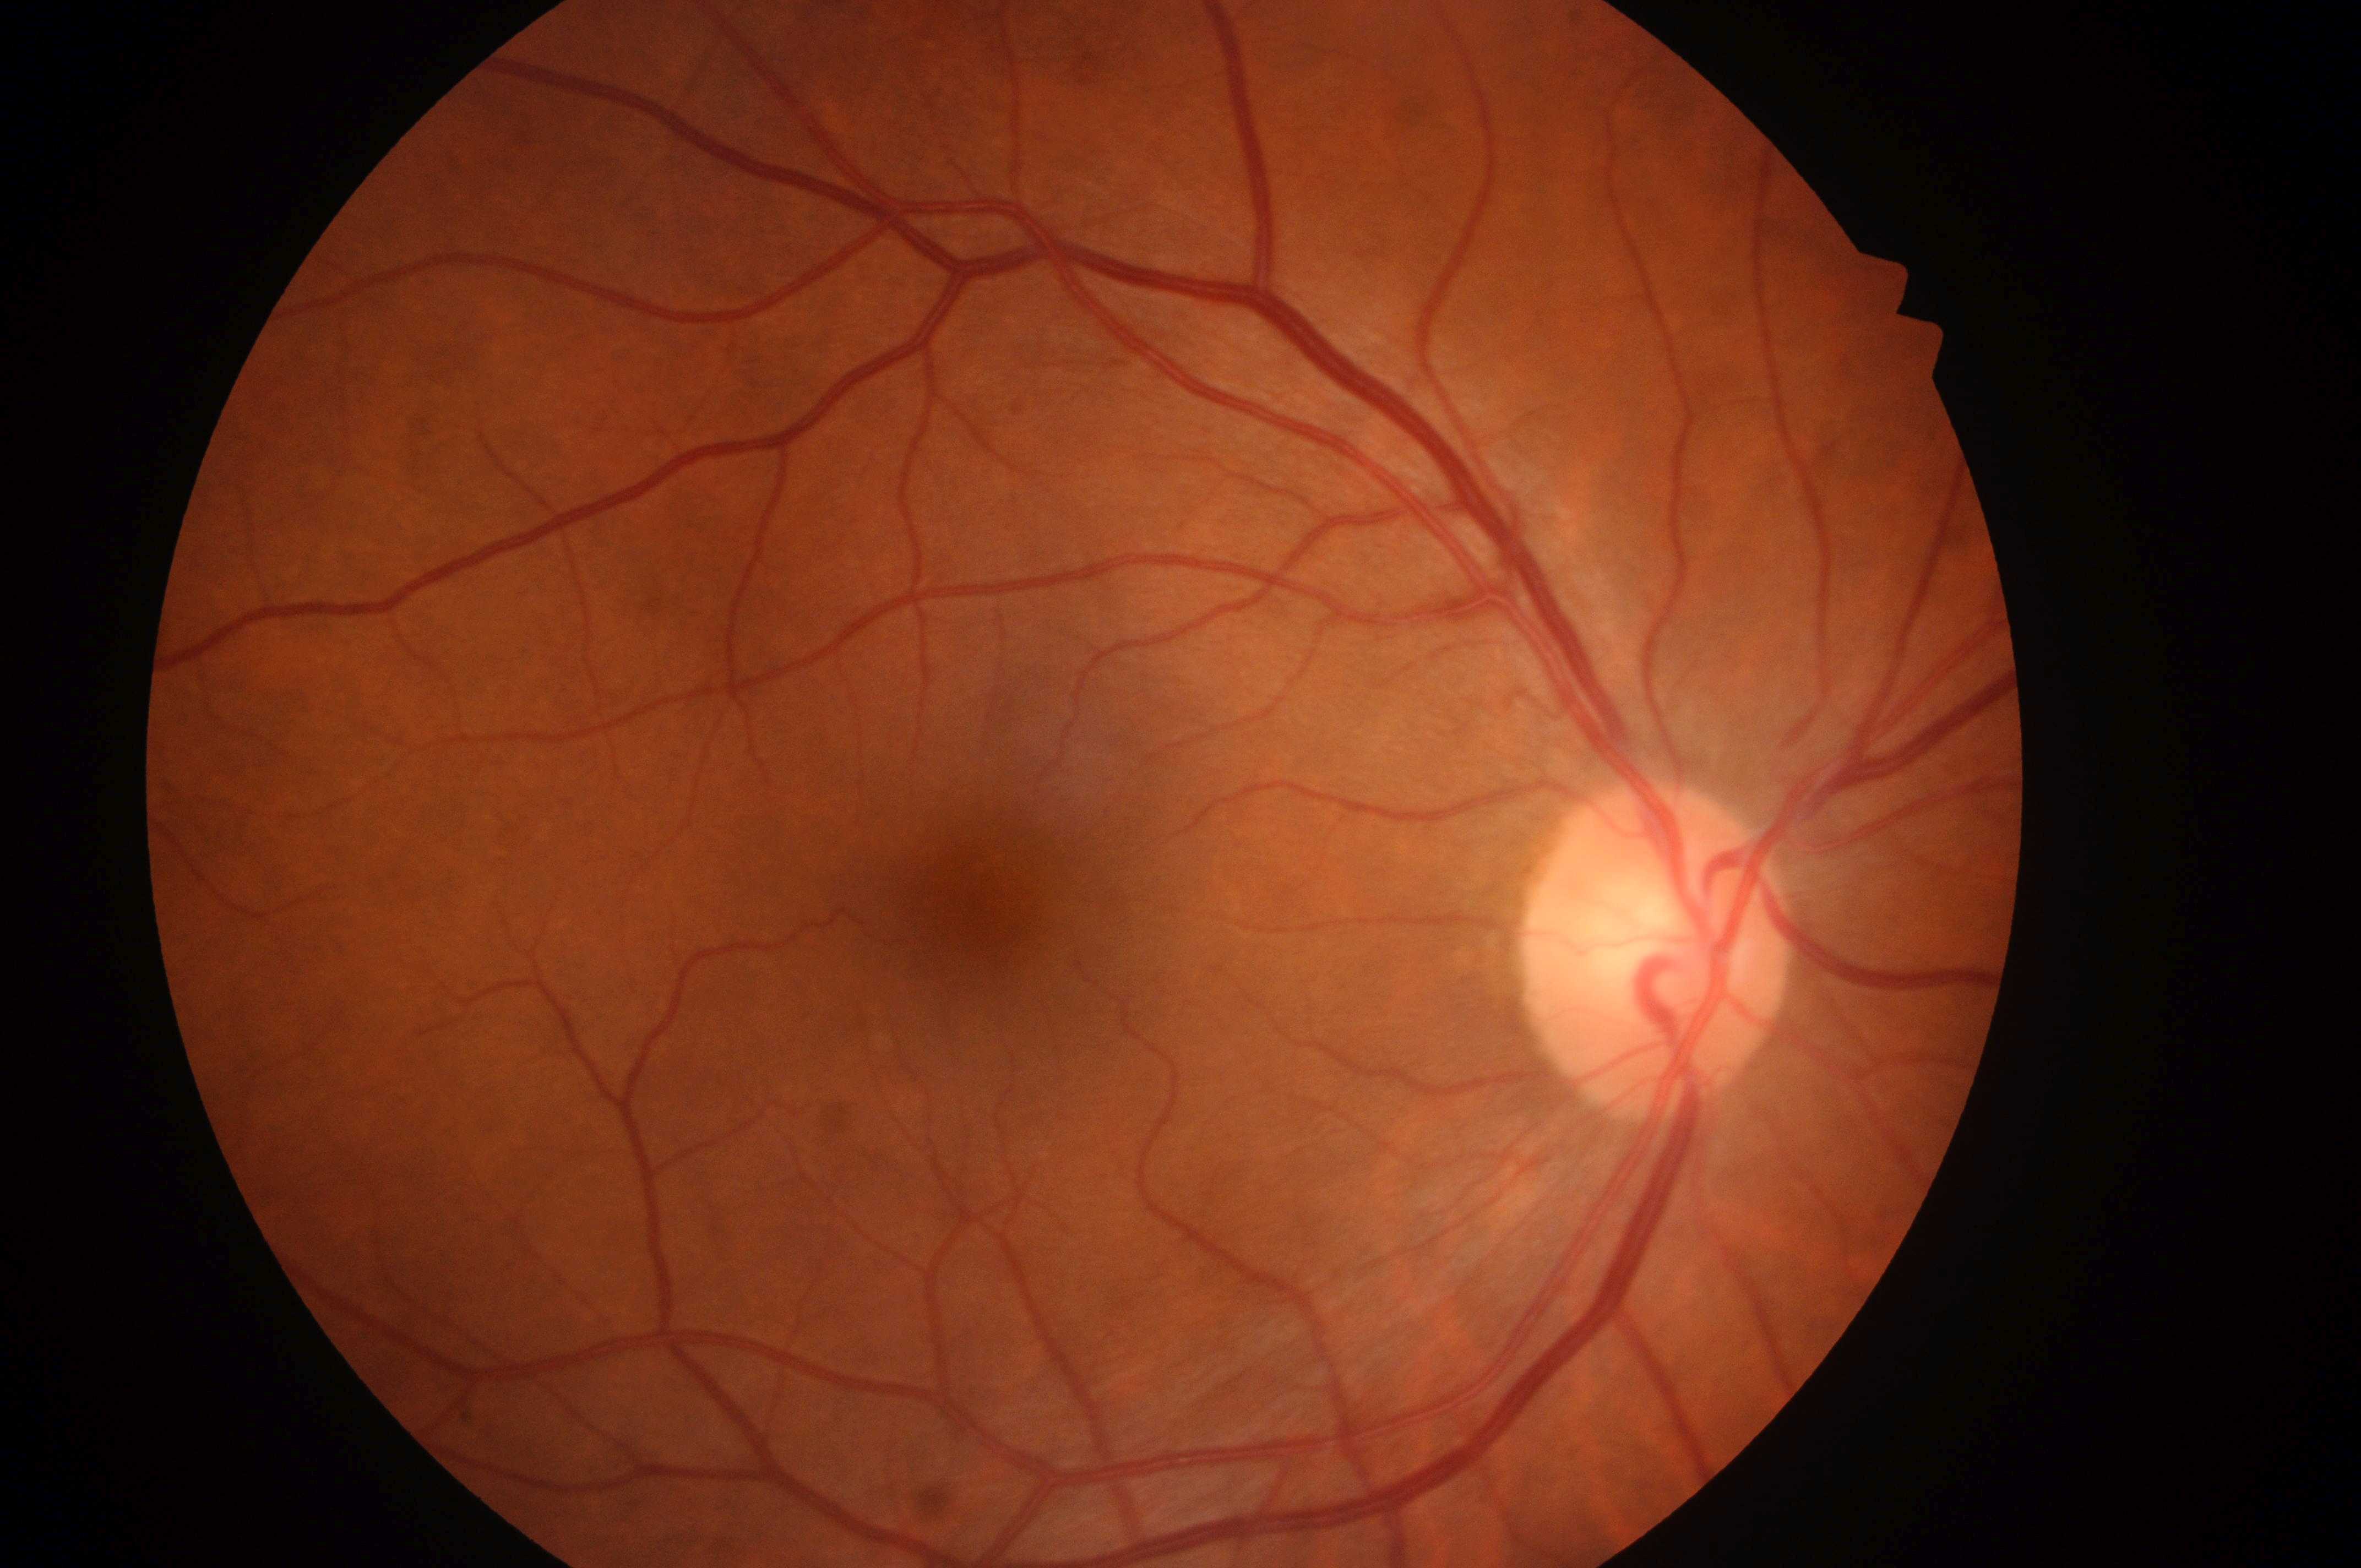
Fovea located at x=980, y=905.
Diabetic retinopathy severity: 0/4.
Risk of diabetic macular edema is 0/2.
The image shows the right eye.
Optic disc: x=1650, y=965.
No diabetic retinal disease findings.